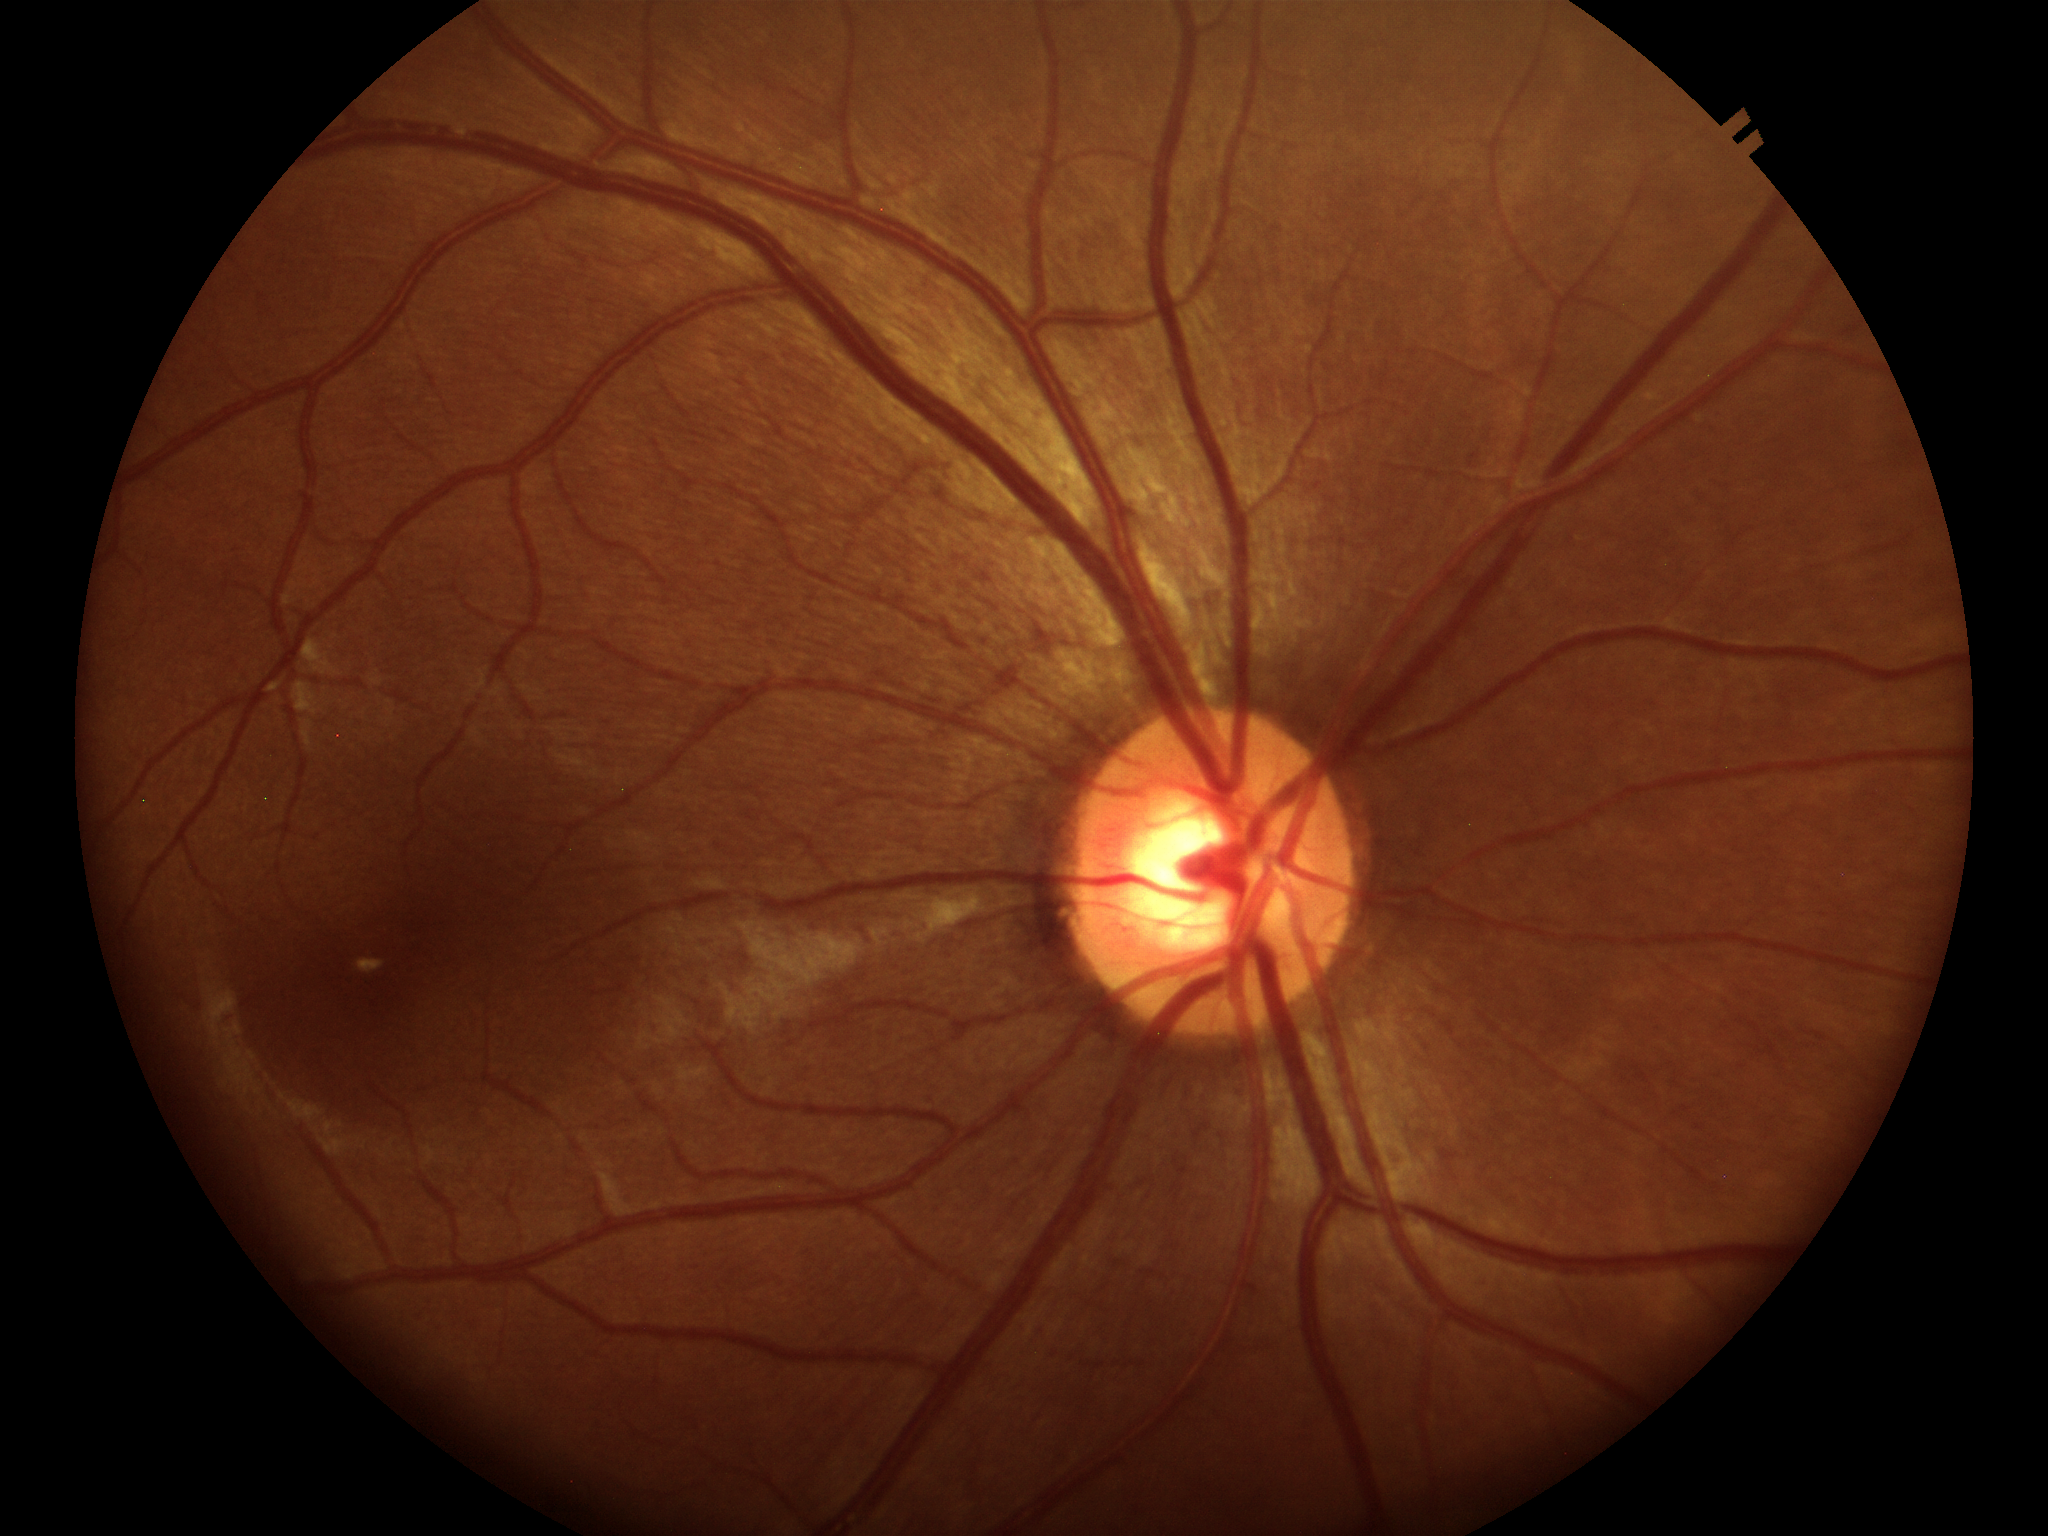
VCDR of 0.57. No signs of glaucoma. ACDR: 0.30. HCDR: 0.52.